Pediatric wide-field fundus photograph · Clarity RetCam 3, 130° FOV · 640x480px:
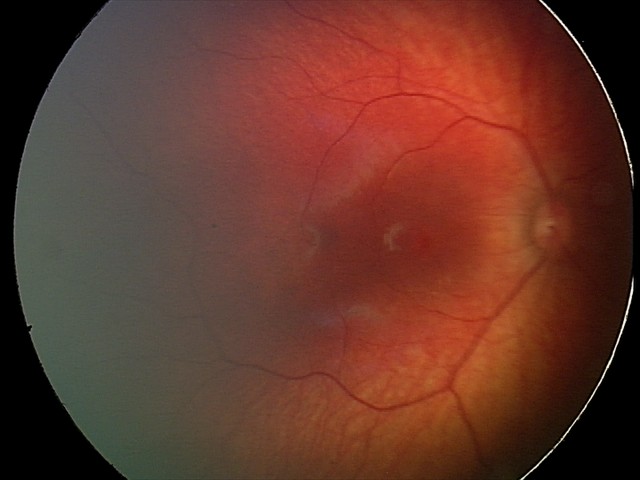 Screening examination consistent with retinal hemorrhages.